Wide-field fundus photograph from neonatal ROP screening: 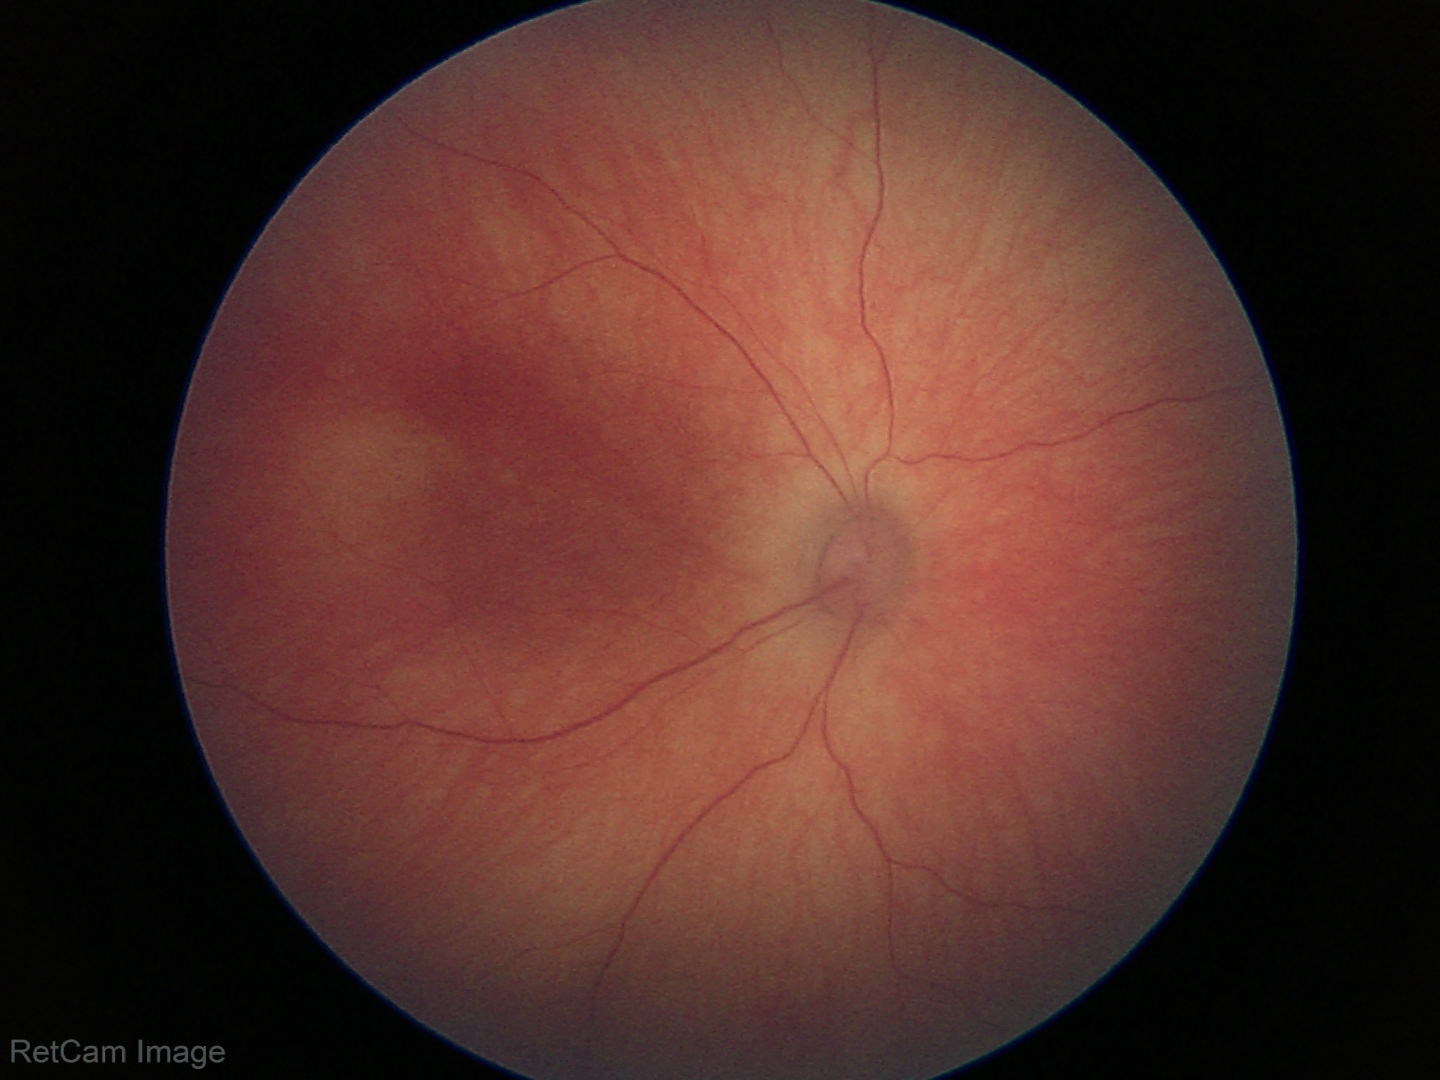 No retinal pathology identified on screening.